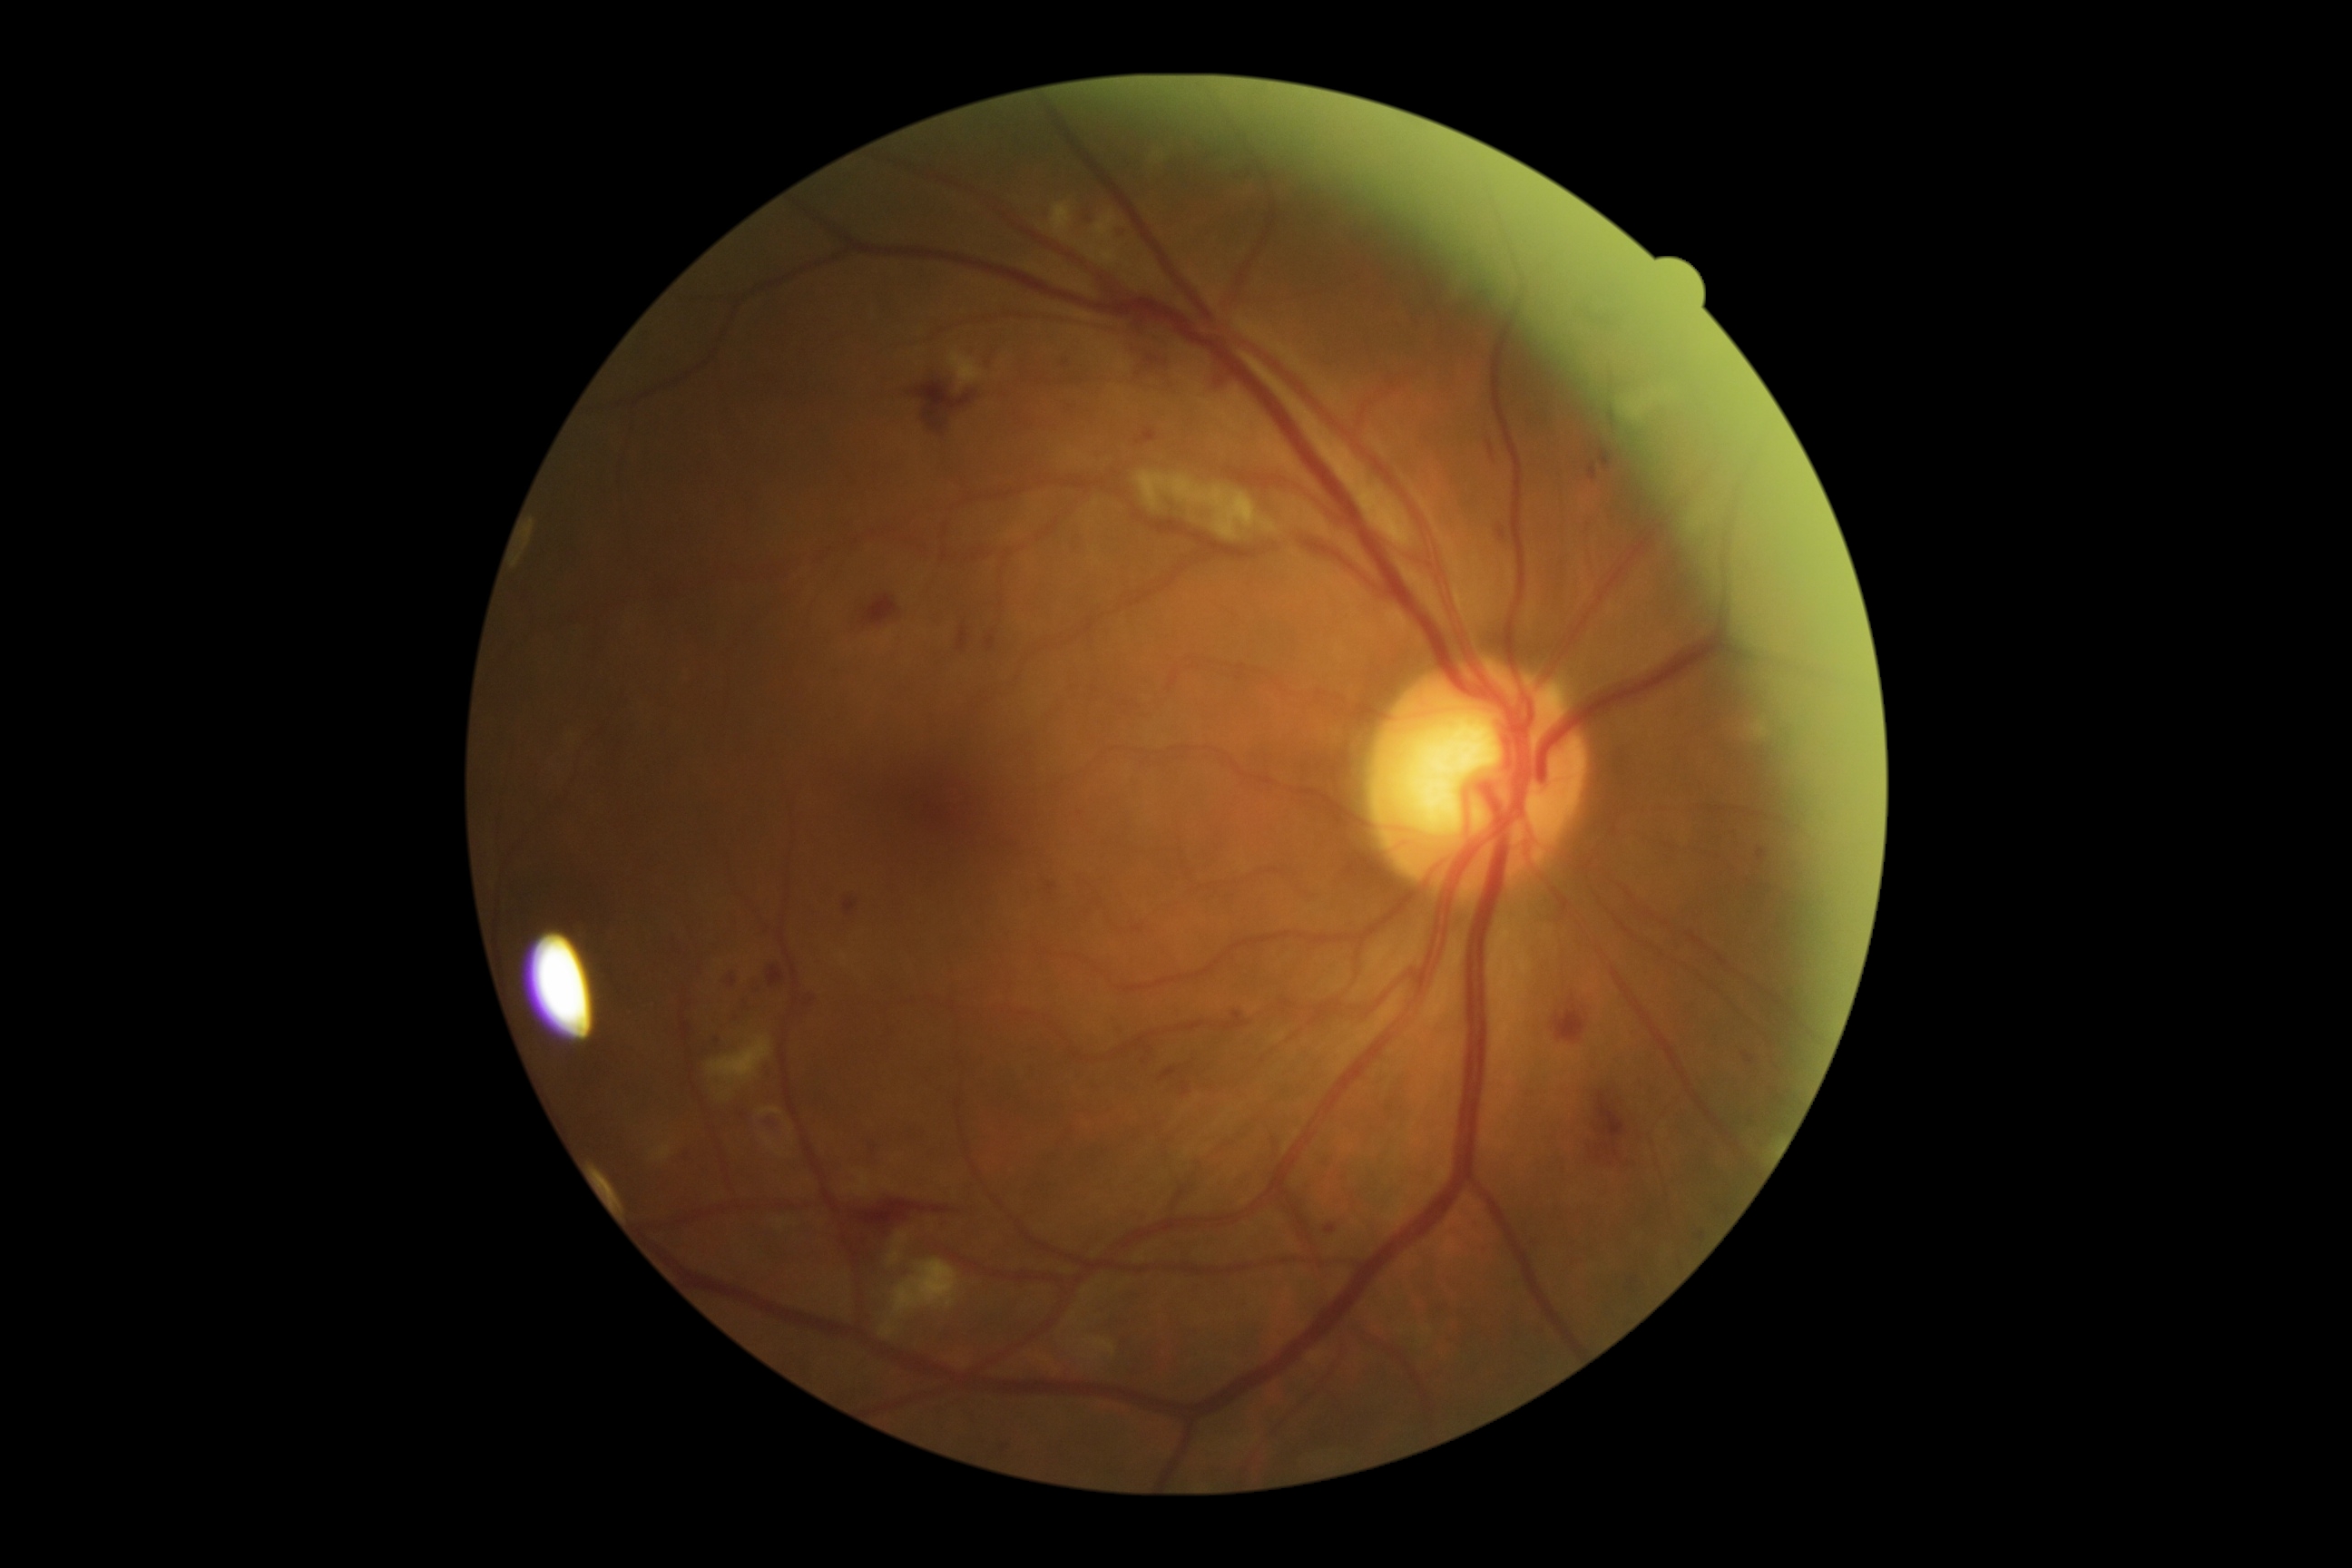
DR stage is 2/4. DR class: non-proliferative diabetic retinopathy.